45° FOV:
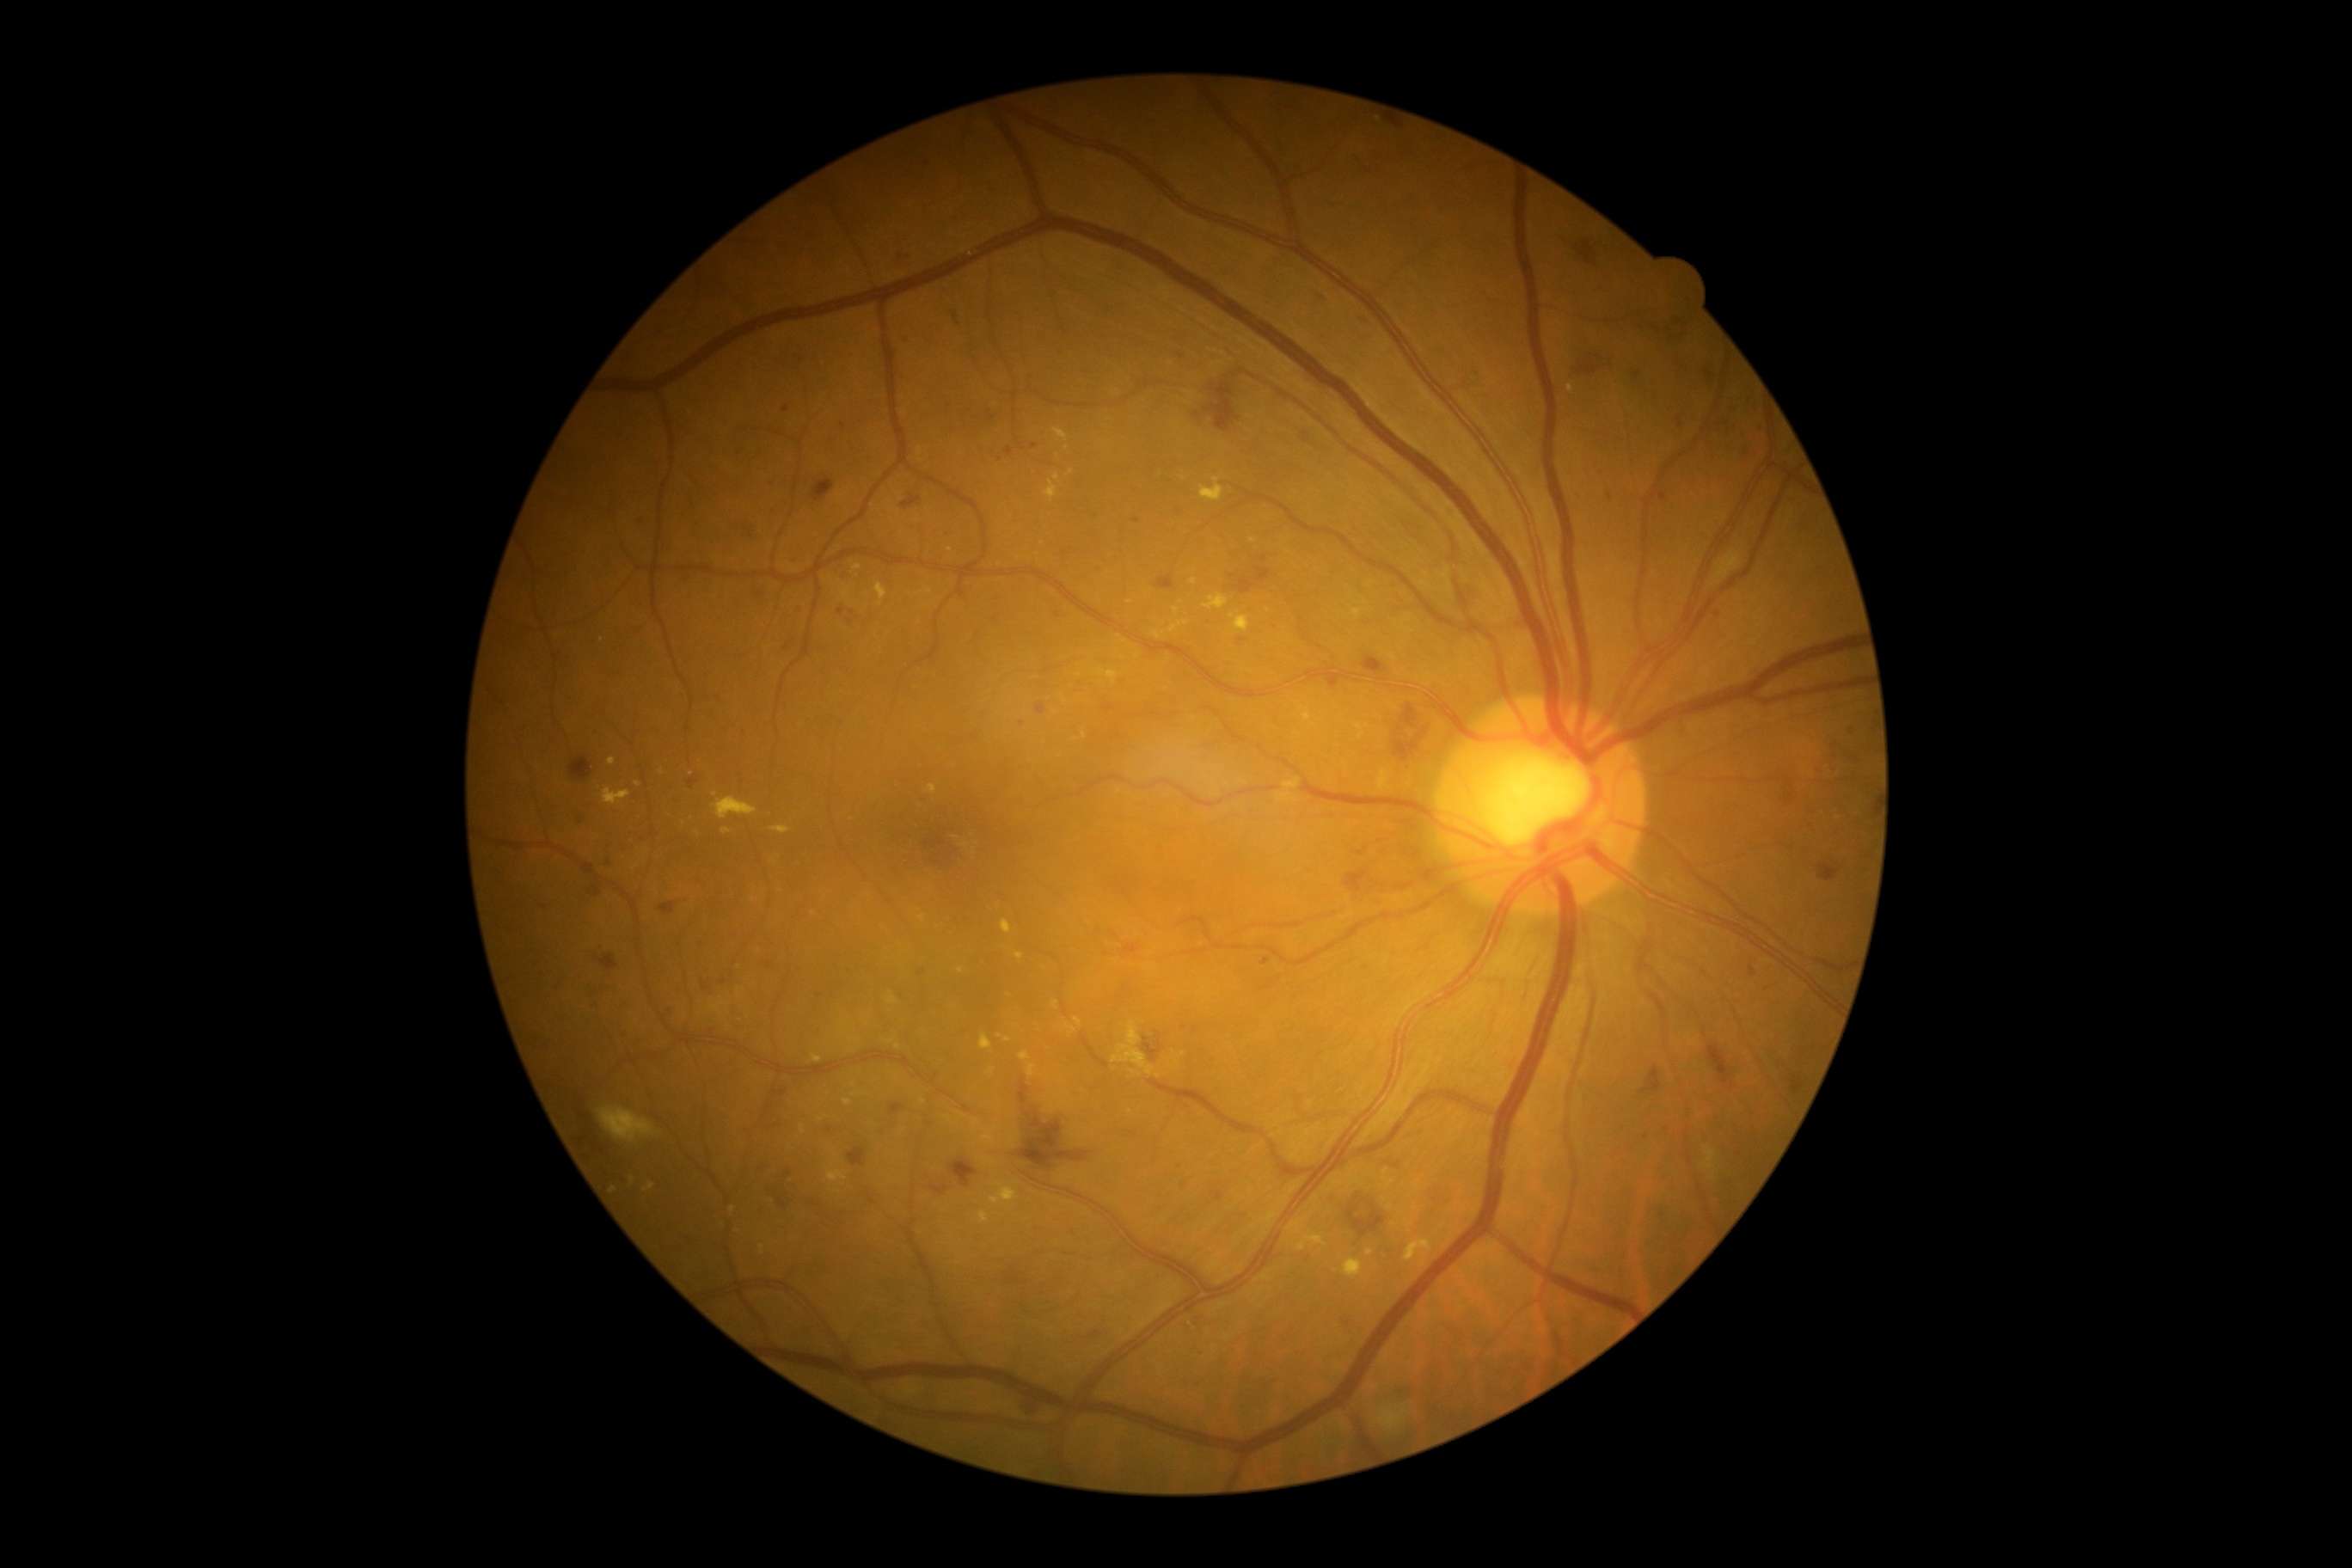

* DR class: non-proliferative diabetic retinopathy
* DR: grade 3 (severe NPDR)